Optic disc-centered crop · non-mydriatic.
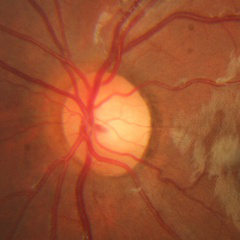
Impression = no signs of glaucoma.